Non-mydriatic fundus camera
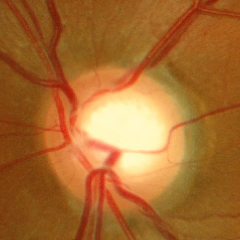 Glaucoma diagnosis = no glaucomatous optic neuropathy.